1240 x 1240 pixels; Phoenix ICON, 100° FOV; pediatric wide-field fundus photograph — 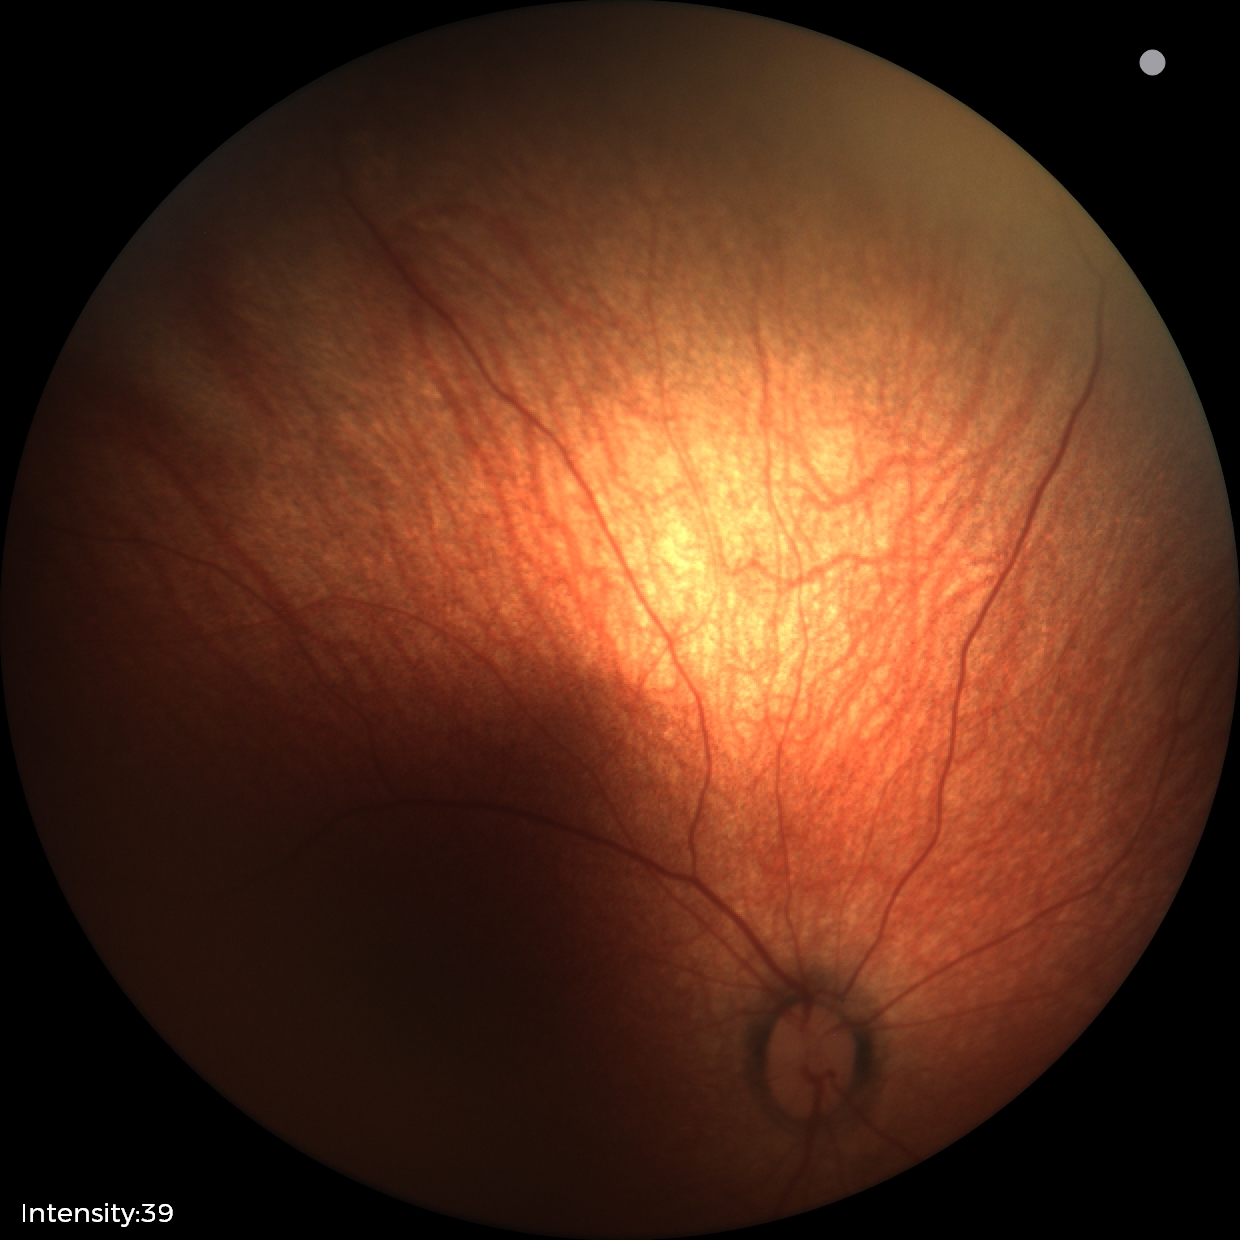 Screening examination with no abnormal retinal findings.